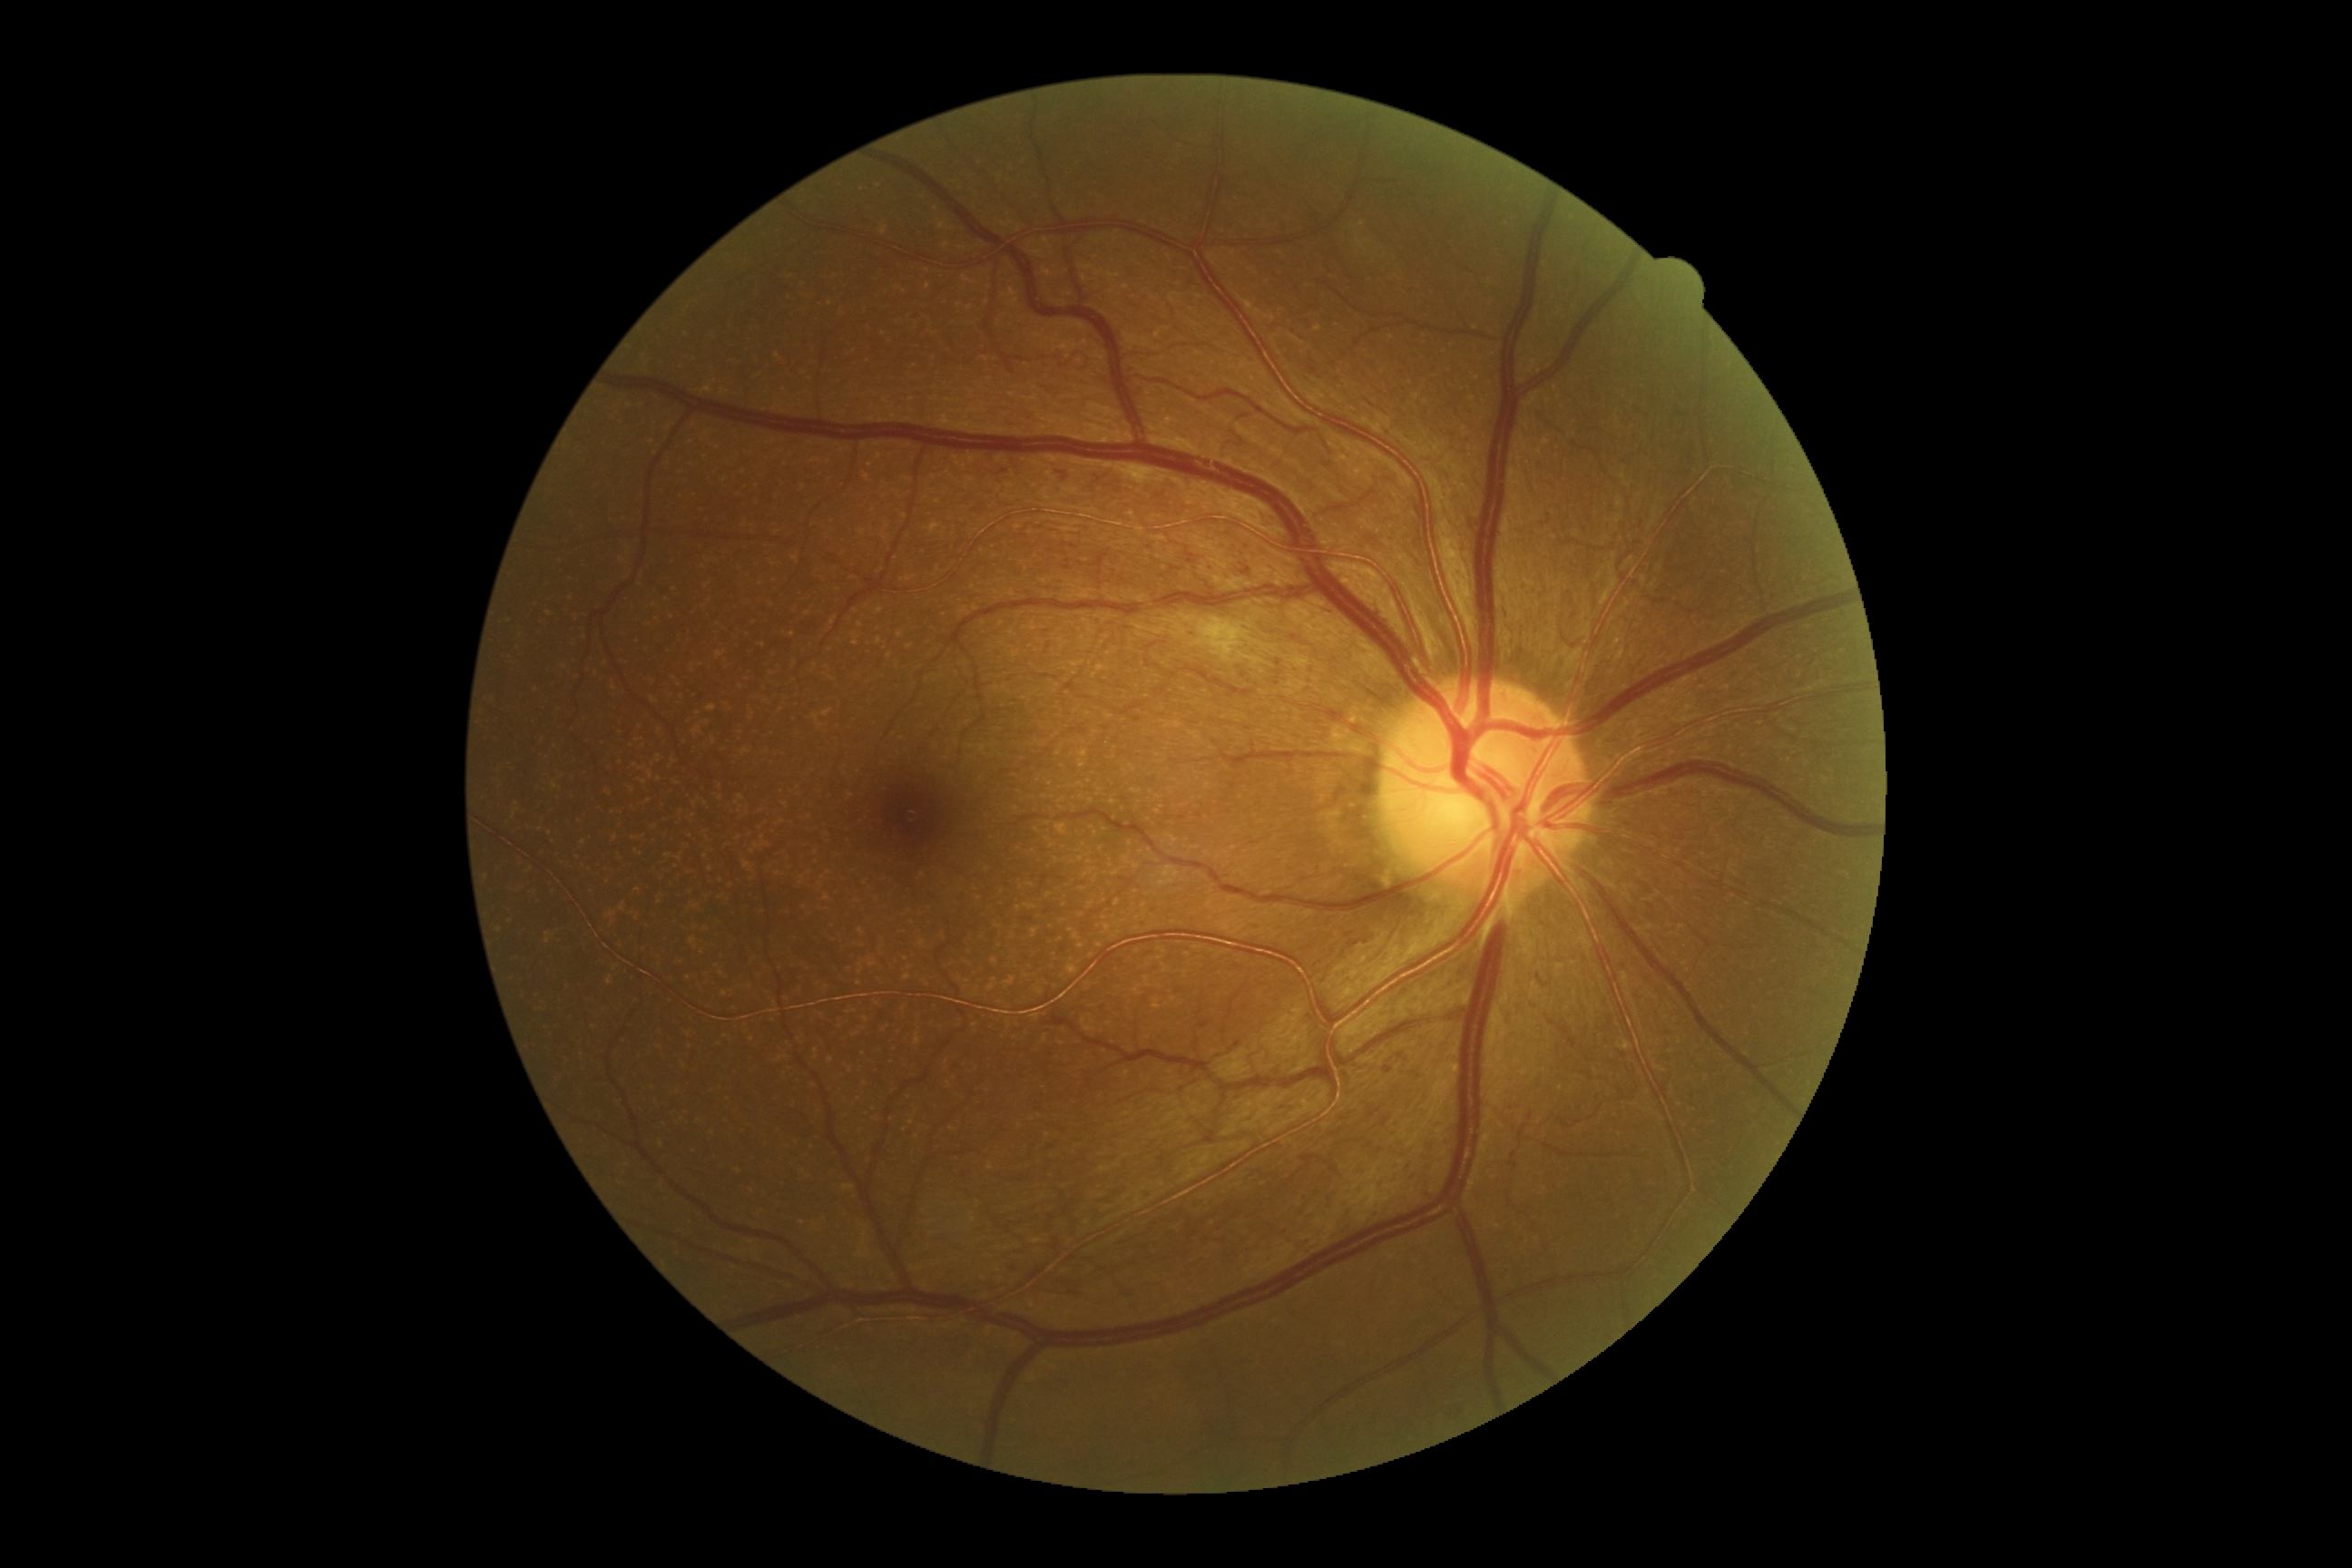 DR class: non-proliferative diabetic retinopathy.
DR: grade 2 (moderate NPDR) — more than just microaneurysms but less than severe NPDR.